FOV: 30 degrees · 52-year-old patient · axial length 27.2 mm — 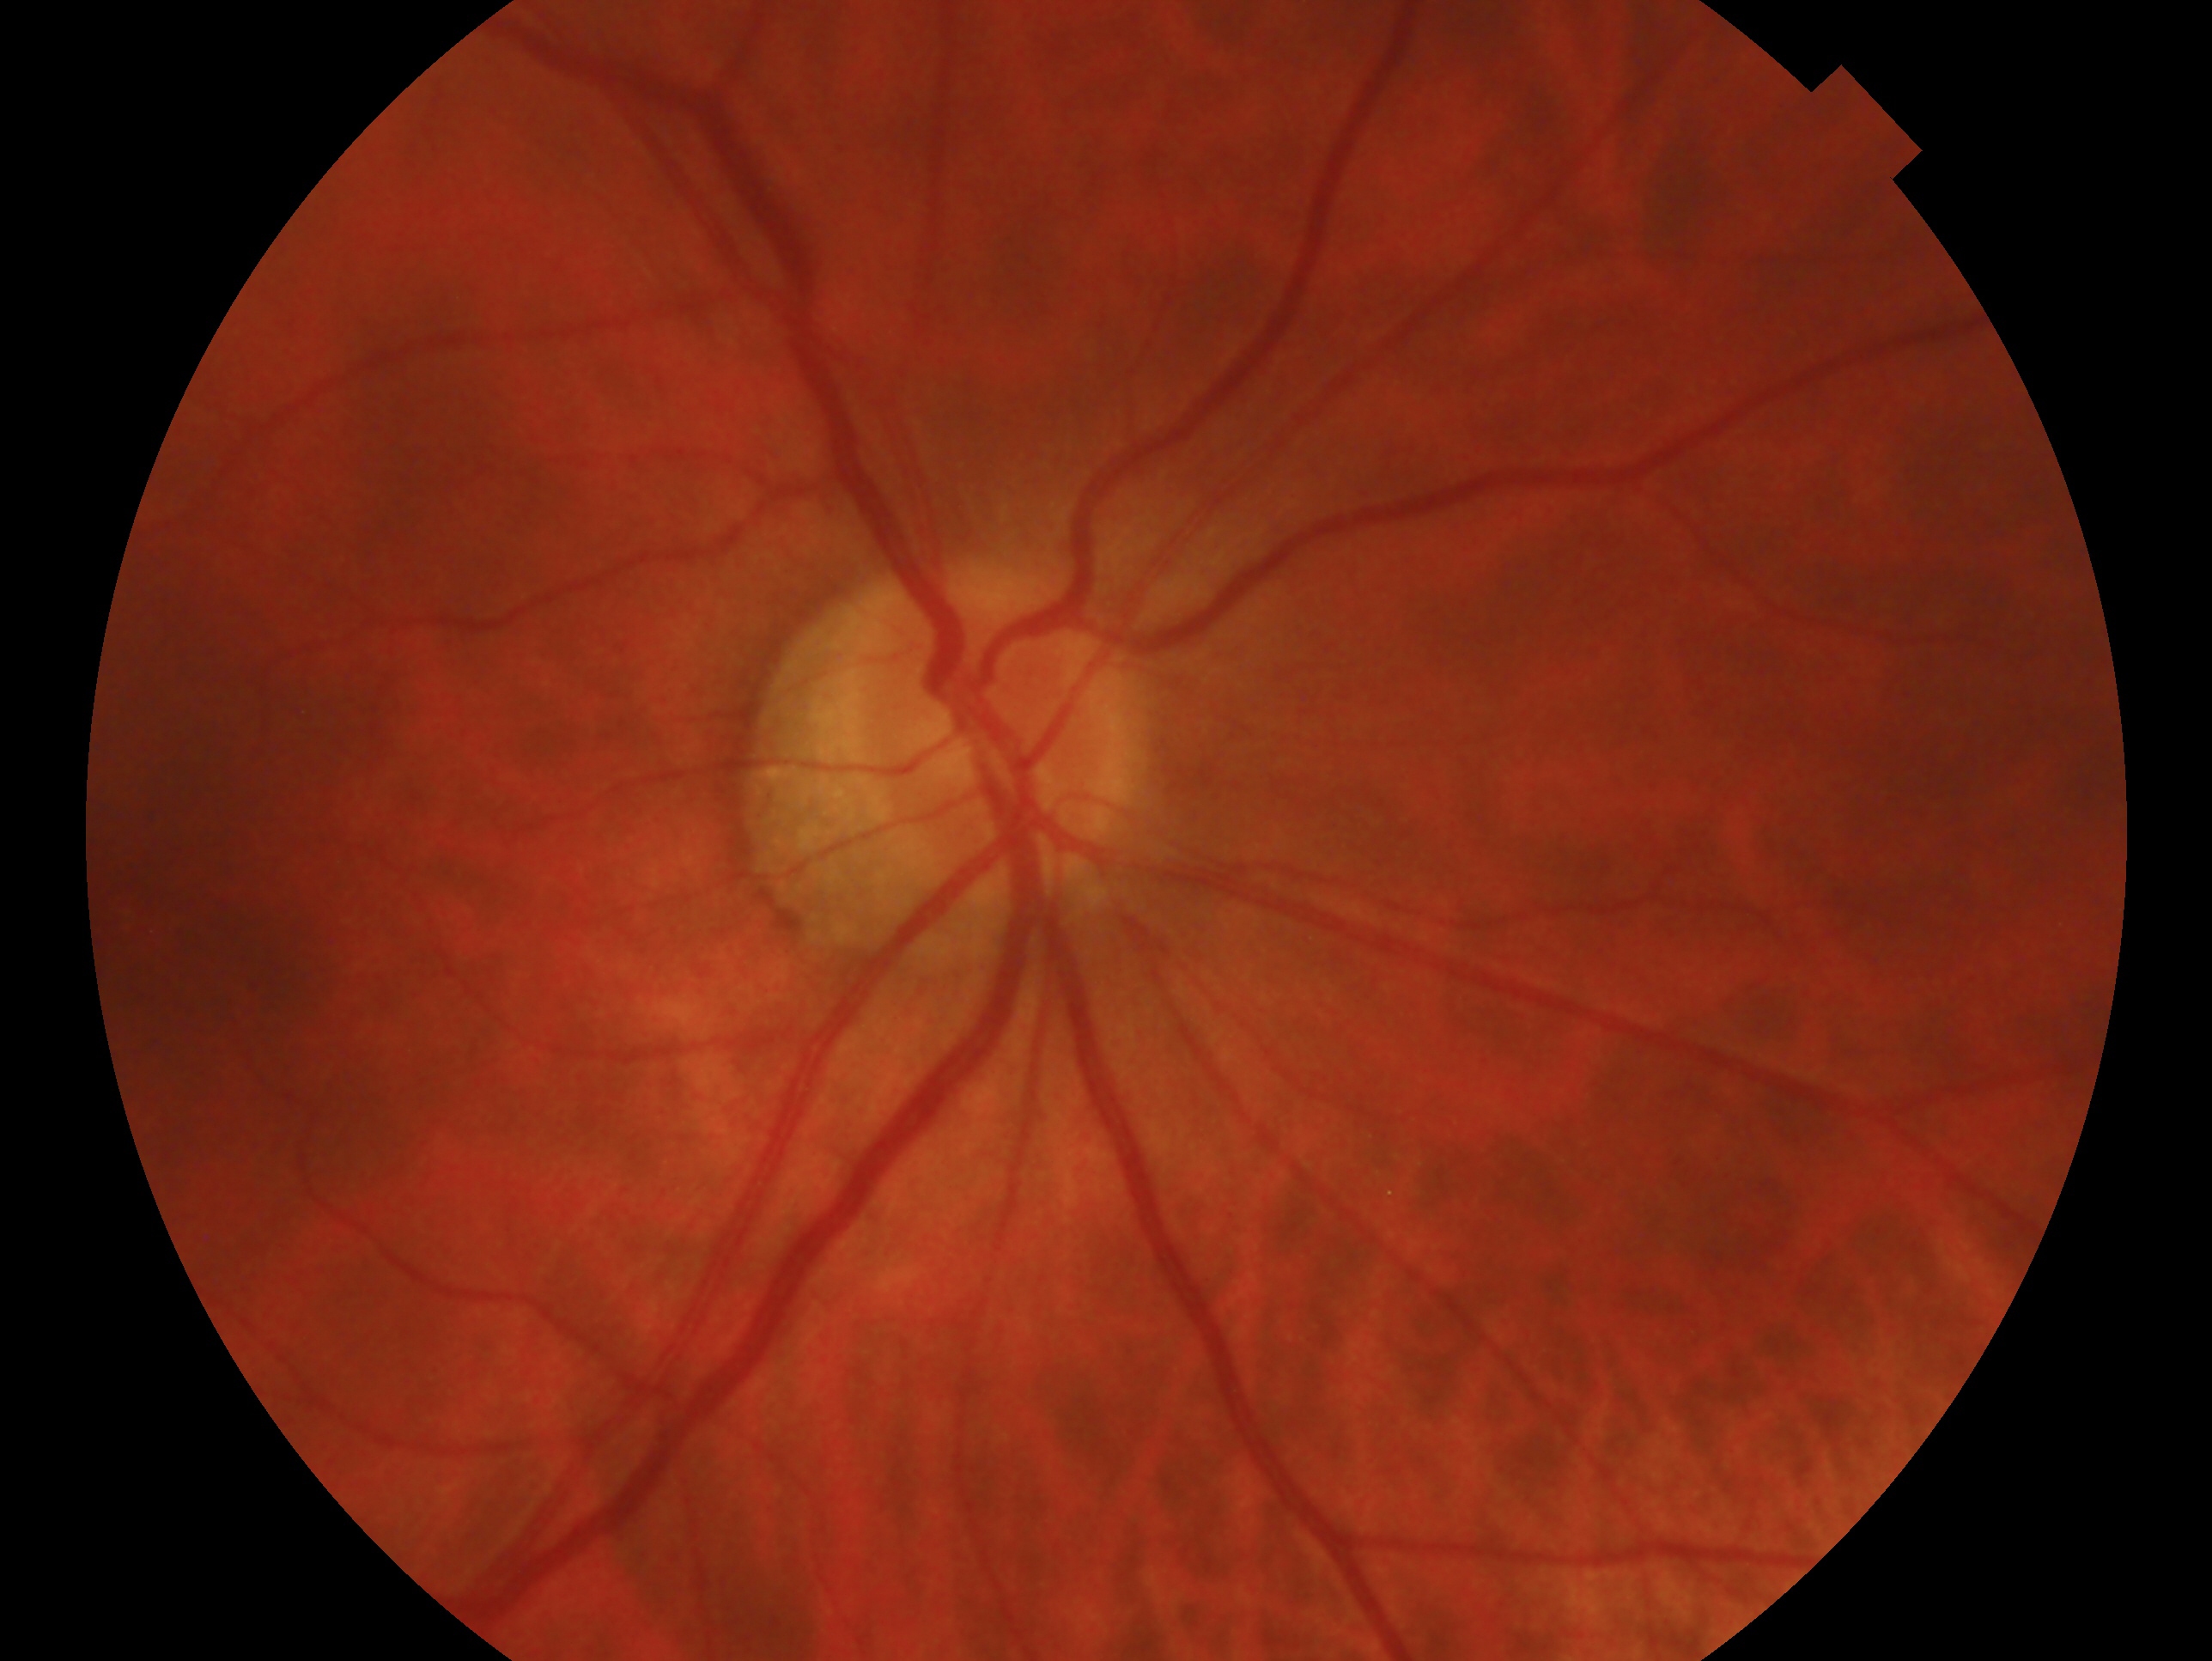 Glaucoma diagnosis: no glaucoma — no clinical evidence of glaucoma in this eye. This is the right eye.